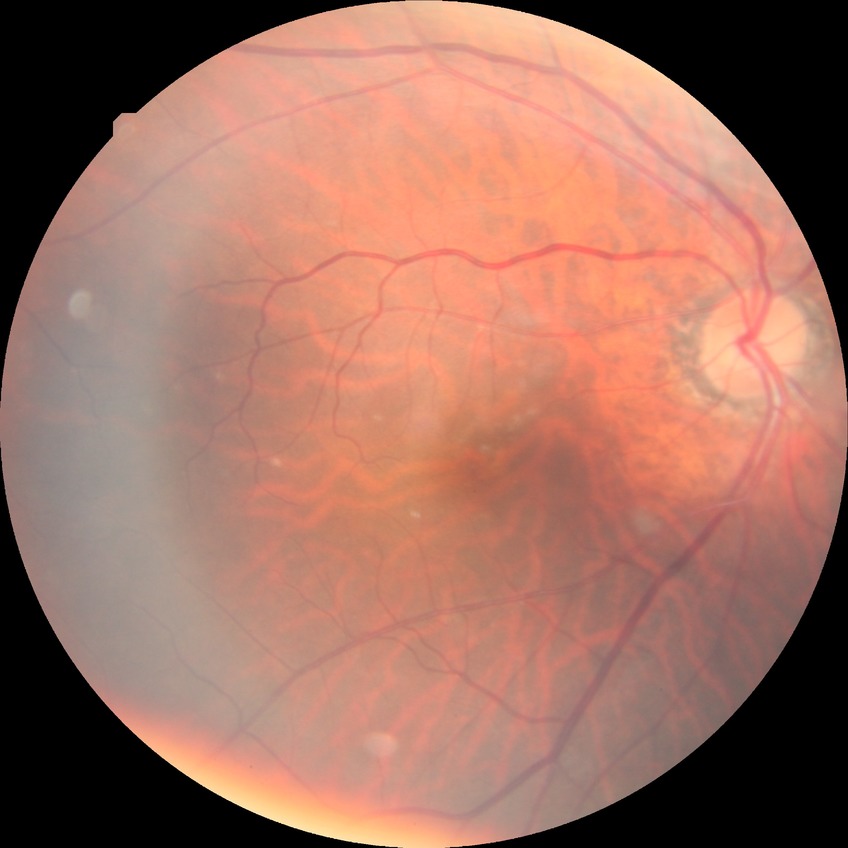

retinopathy grade: no diabetic retinopathy.